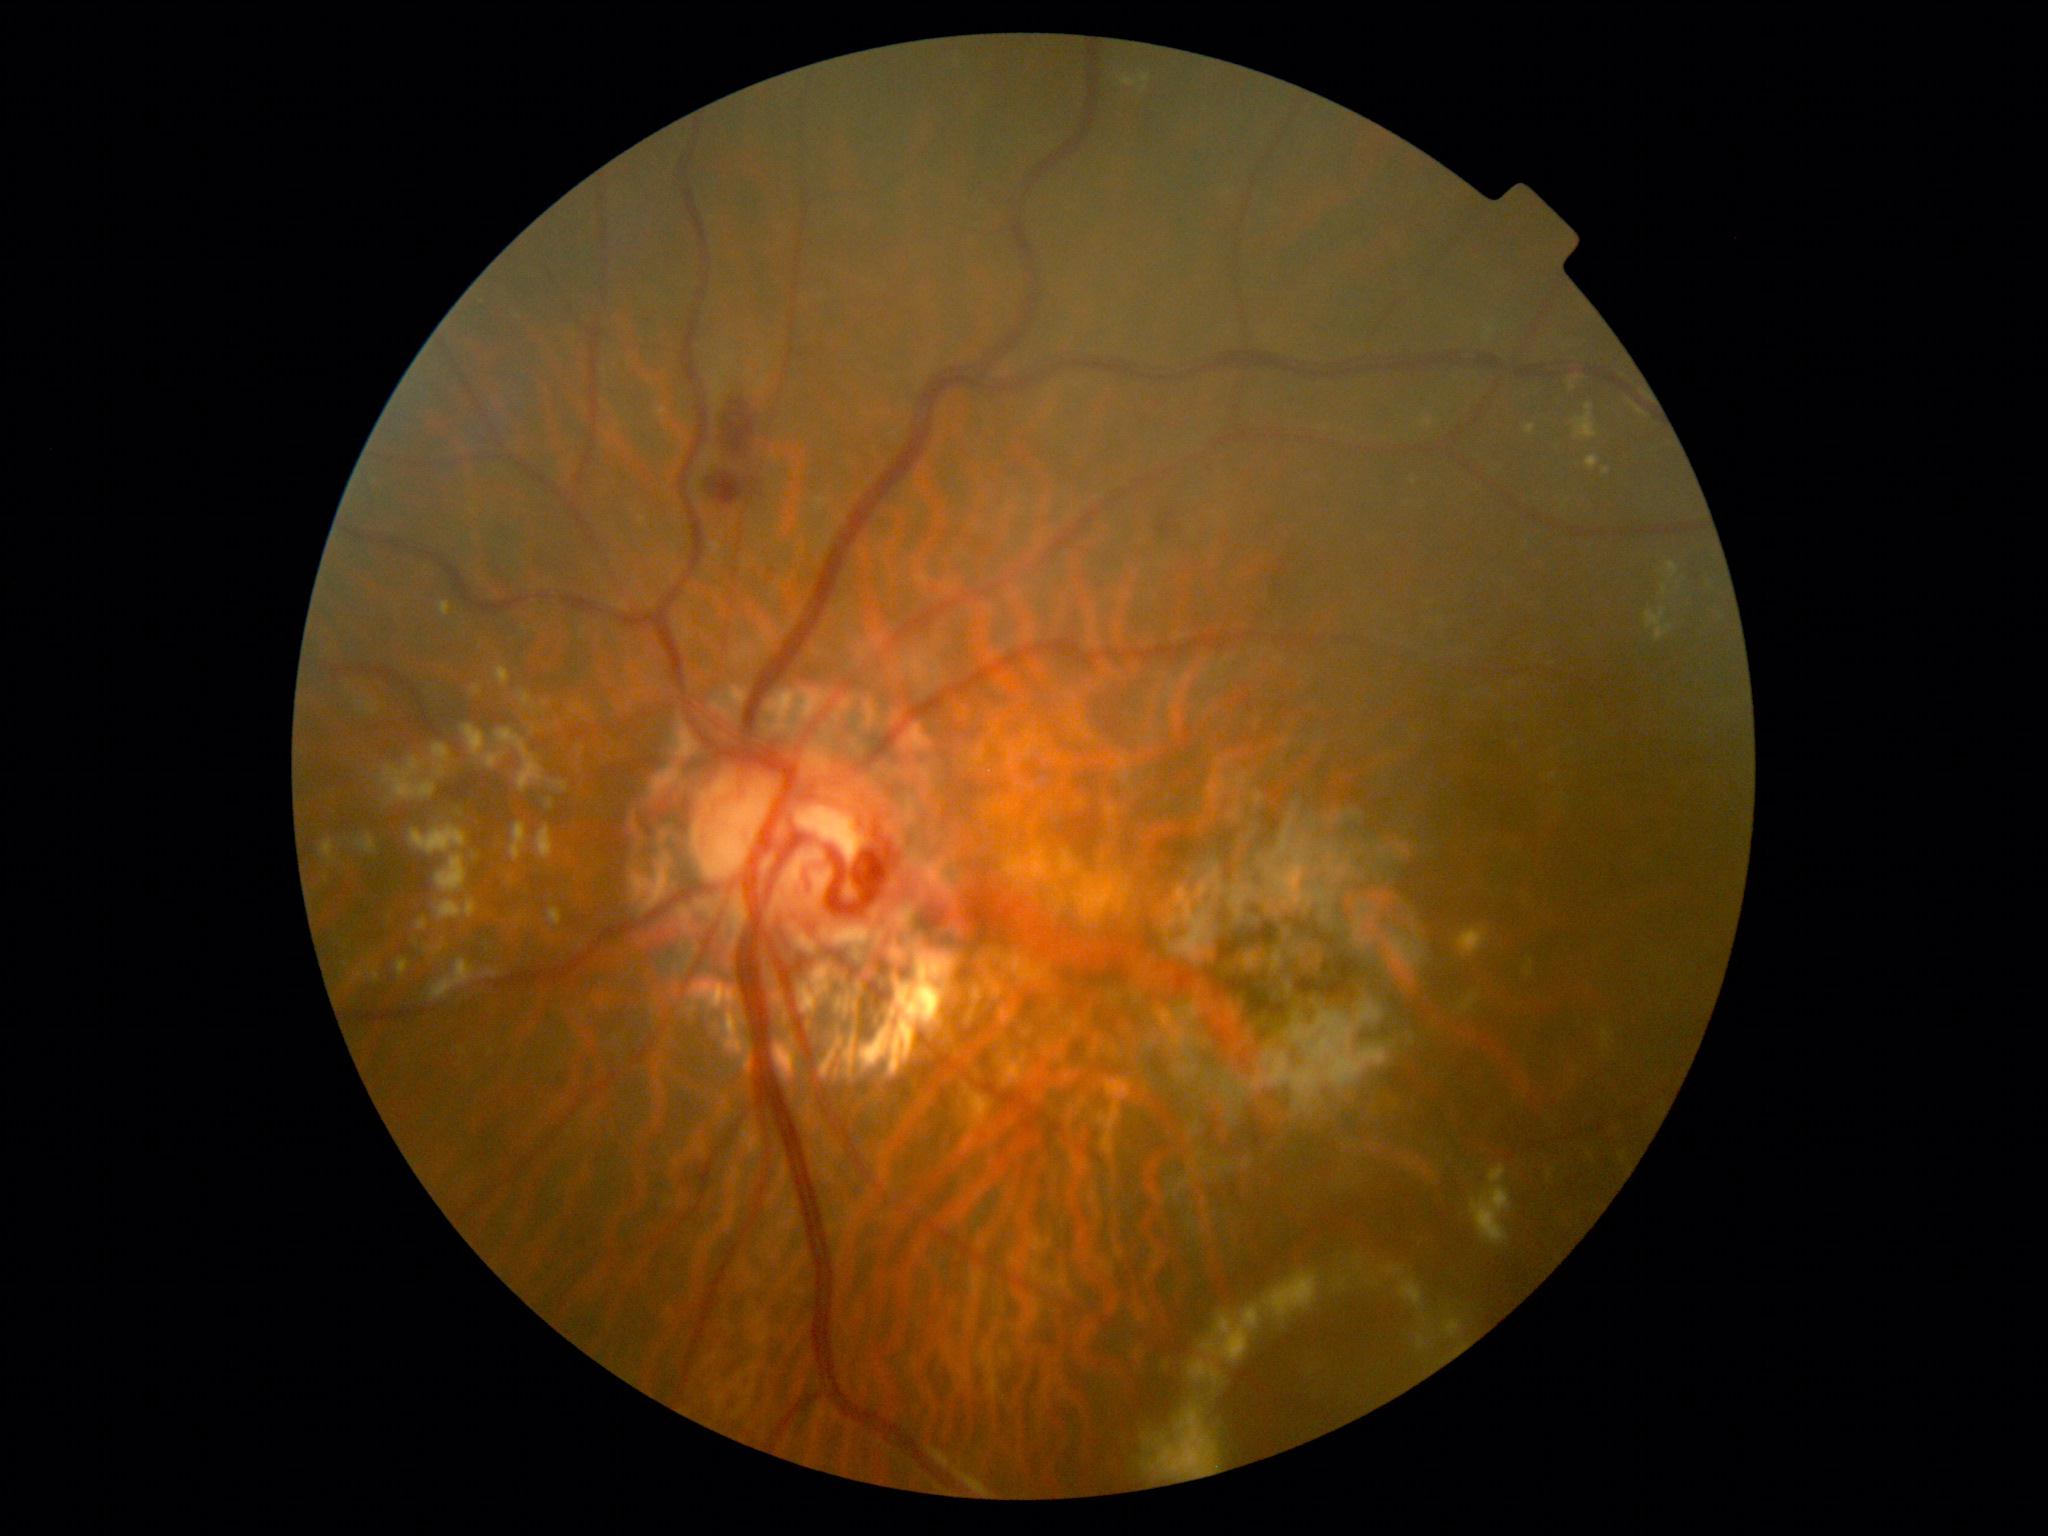 diabetic retinopathy (DR): 2/4, DR class: non-proliferative diabetic retinopathy.